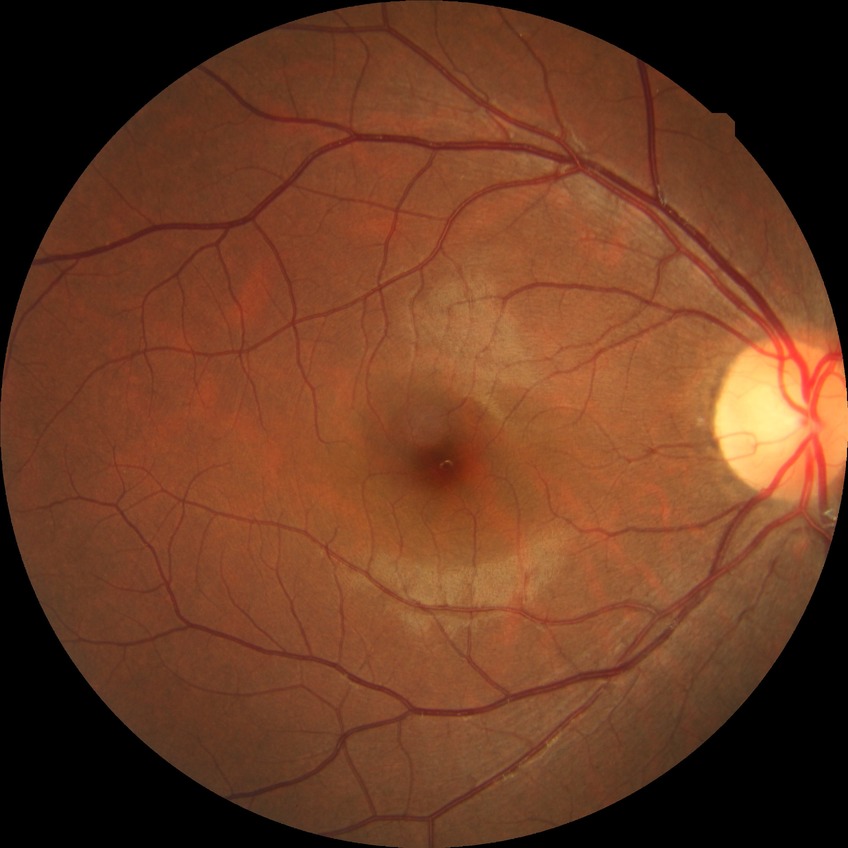
diabetic retinopathy (DR)@NDR (no diabetic retinopathy).